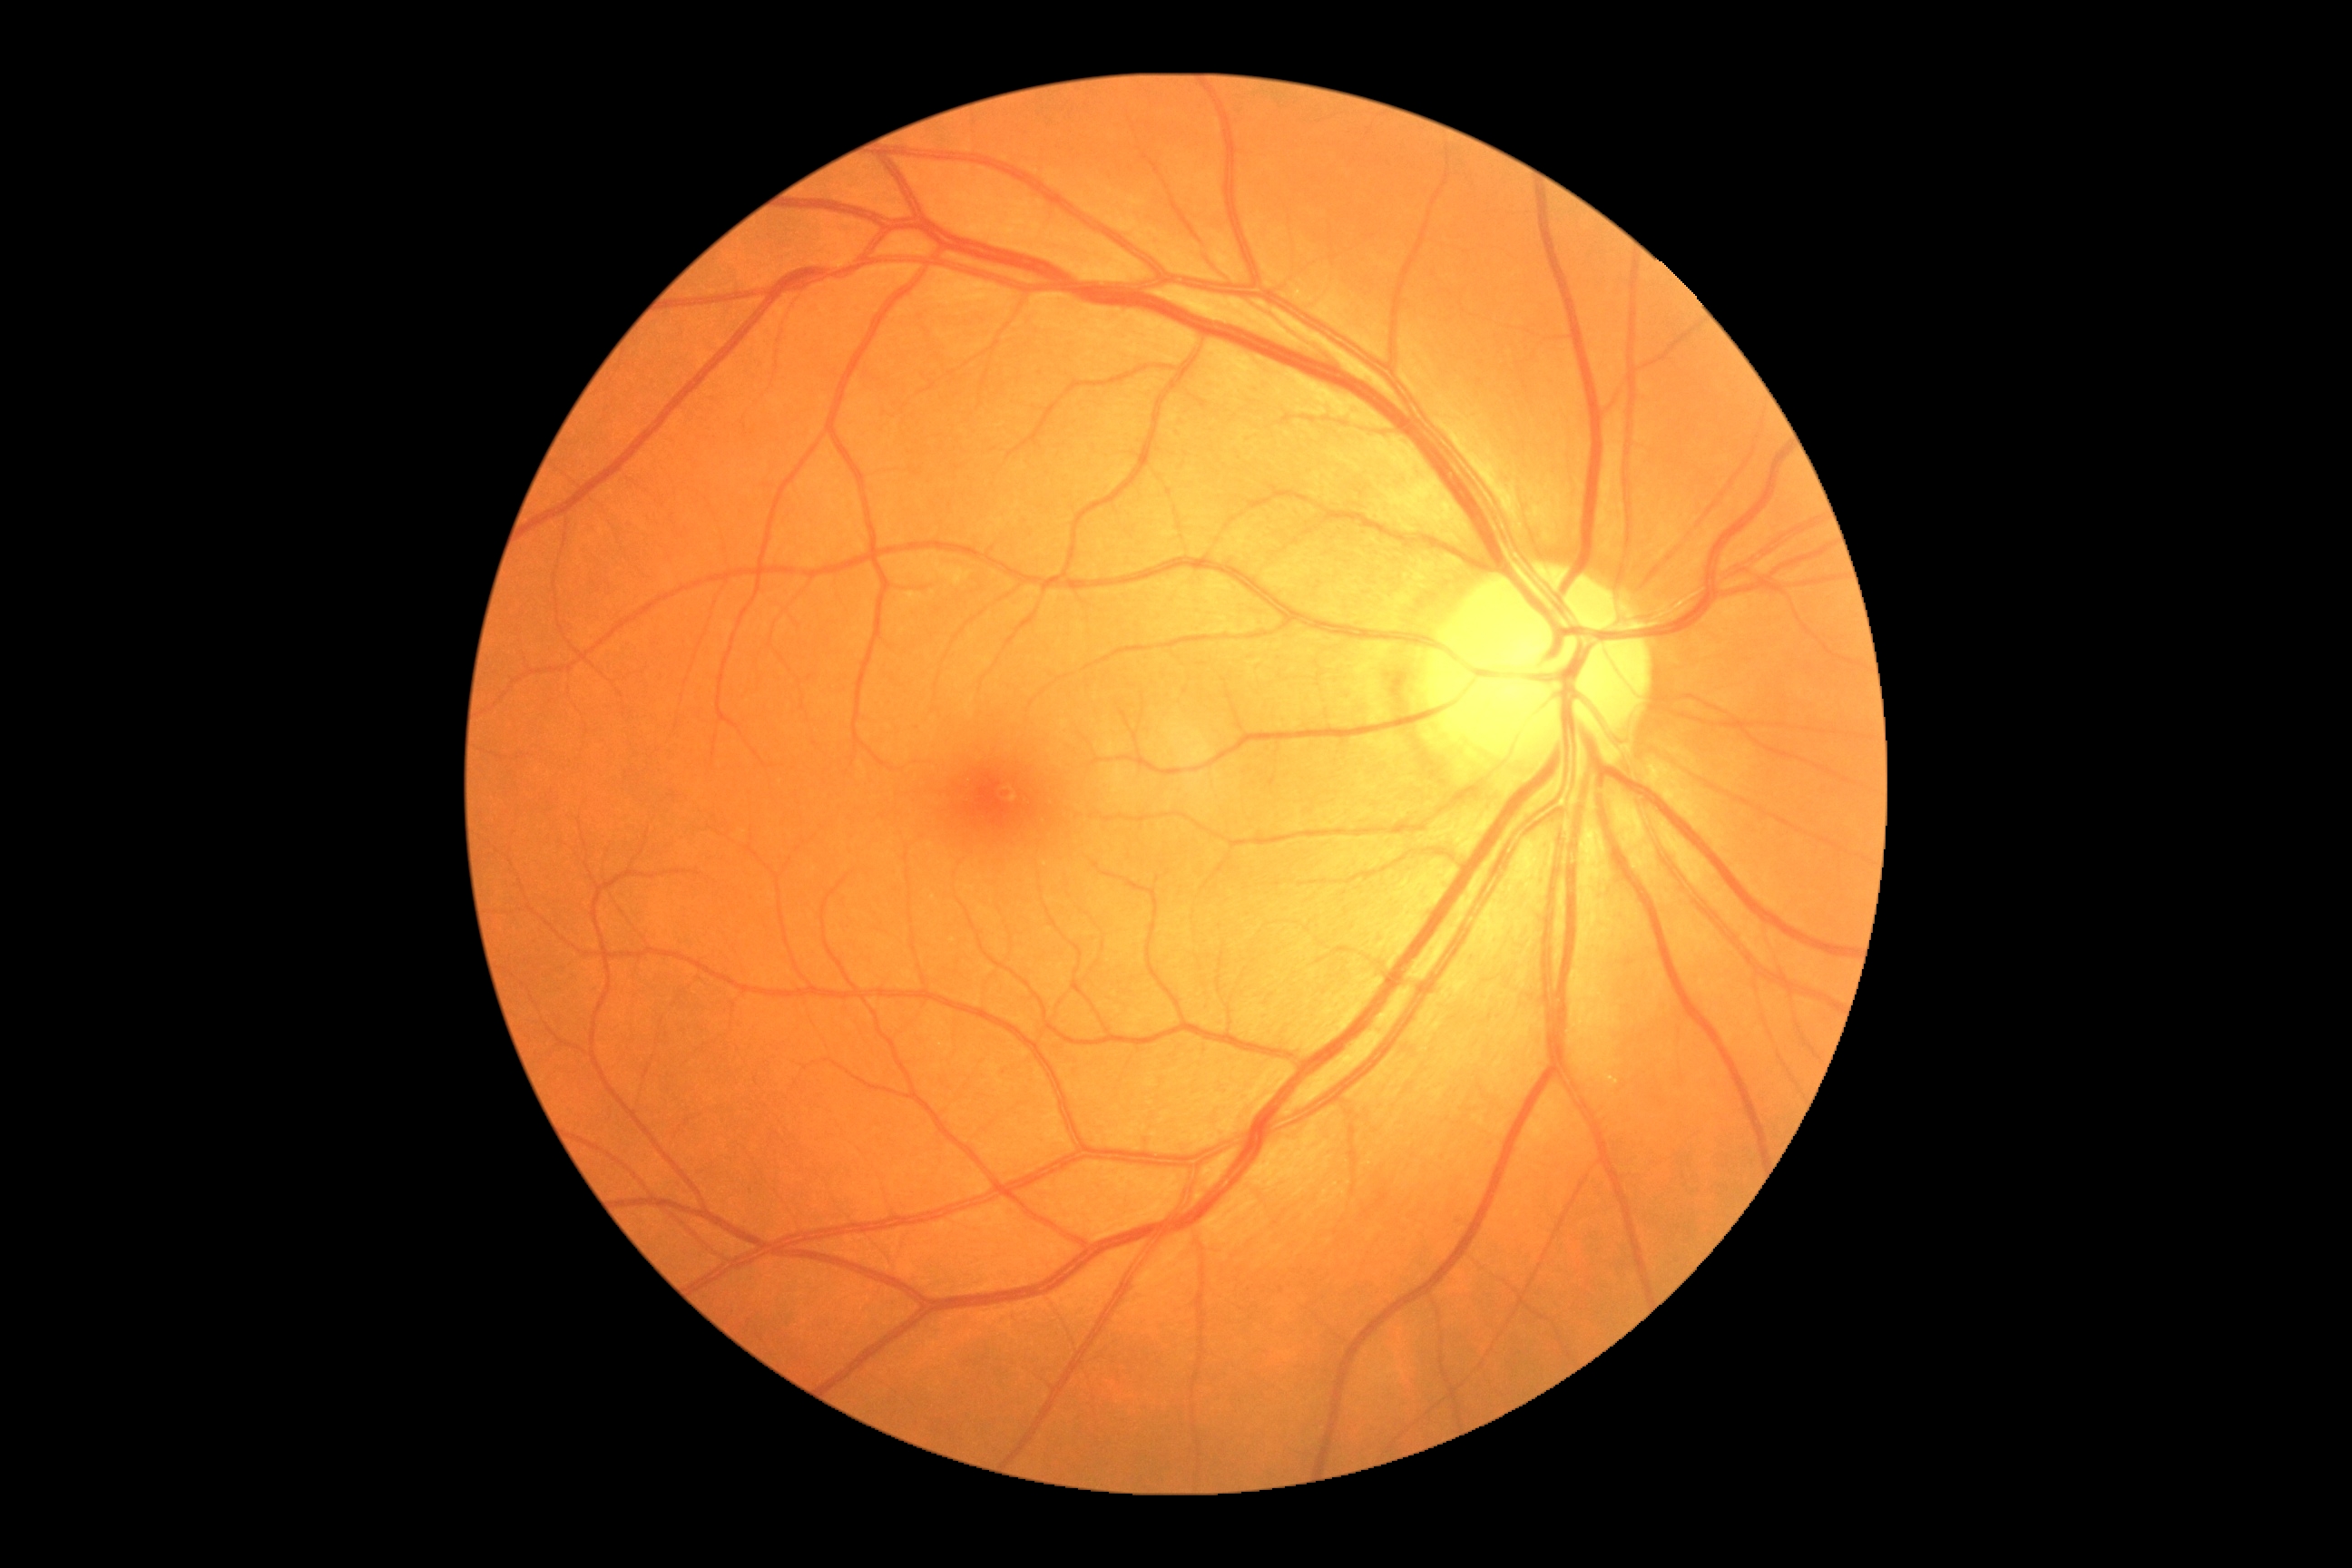

No signs of diabetic retinopathy. Diabetic retinopathy: 0 — no visible signs of diabetic retinopathy.